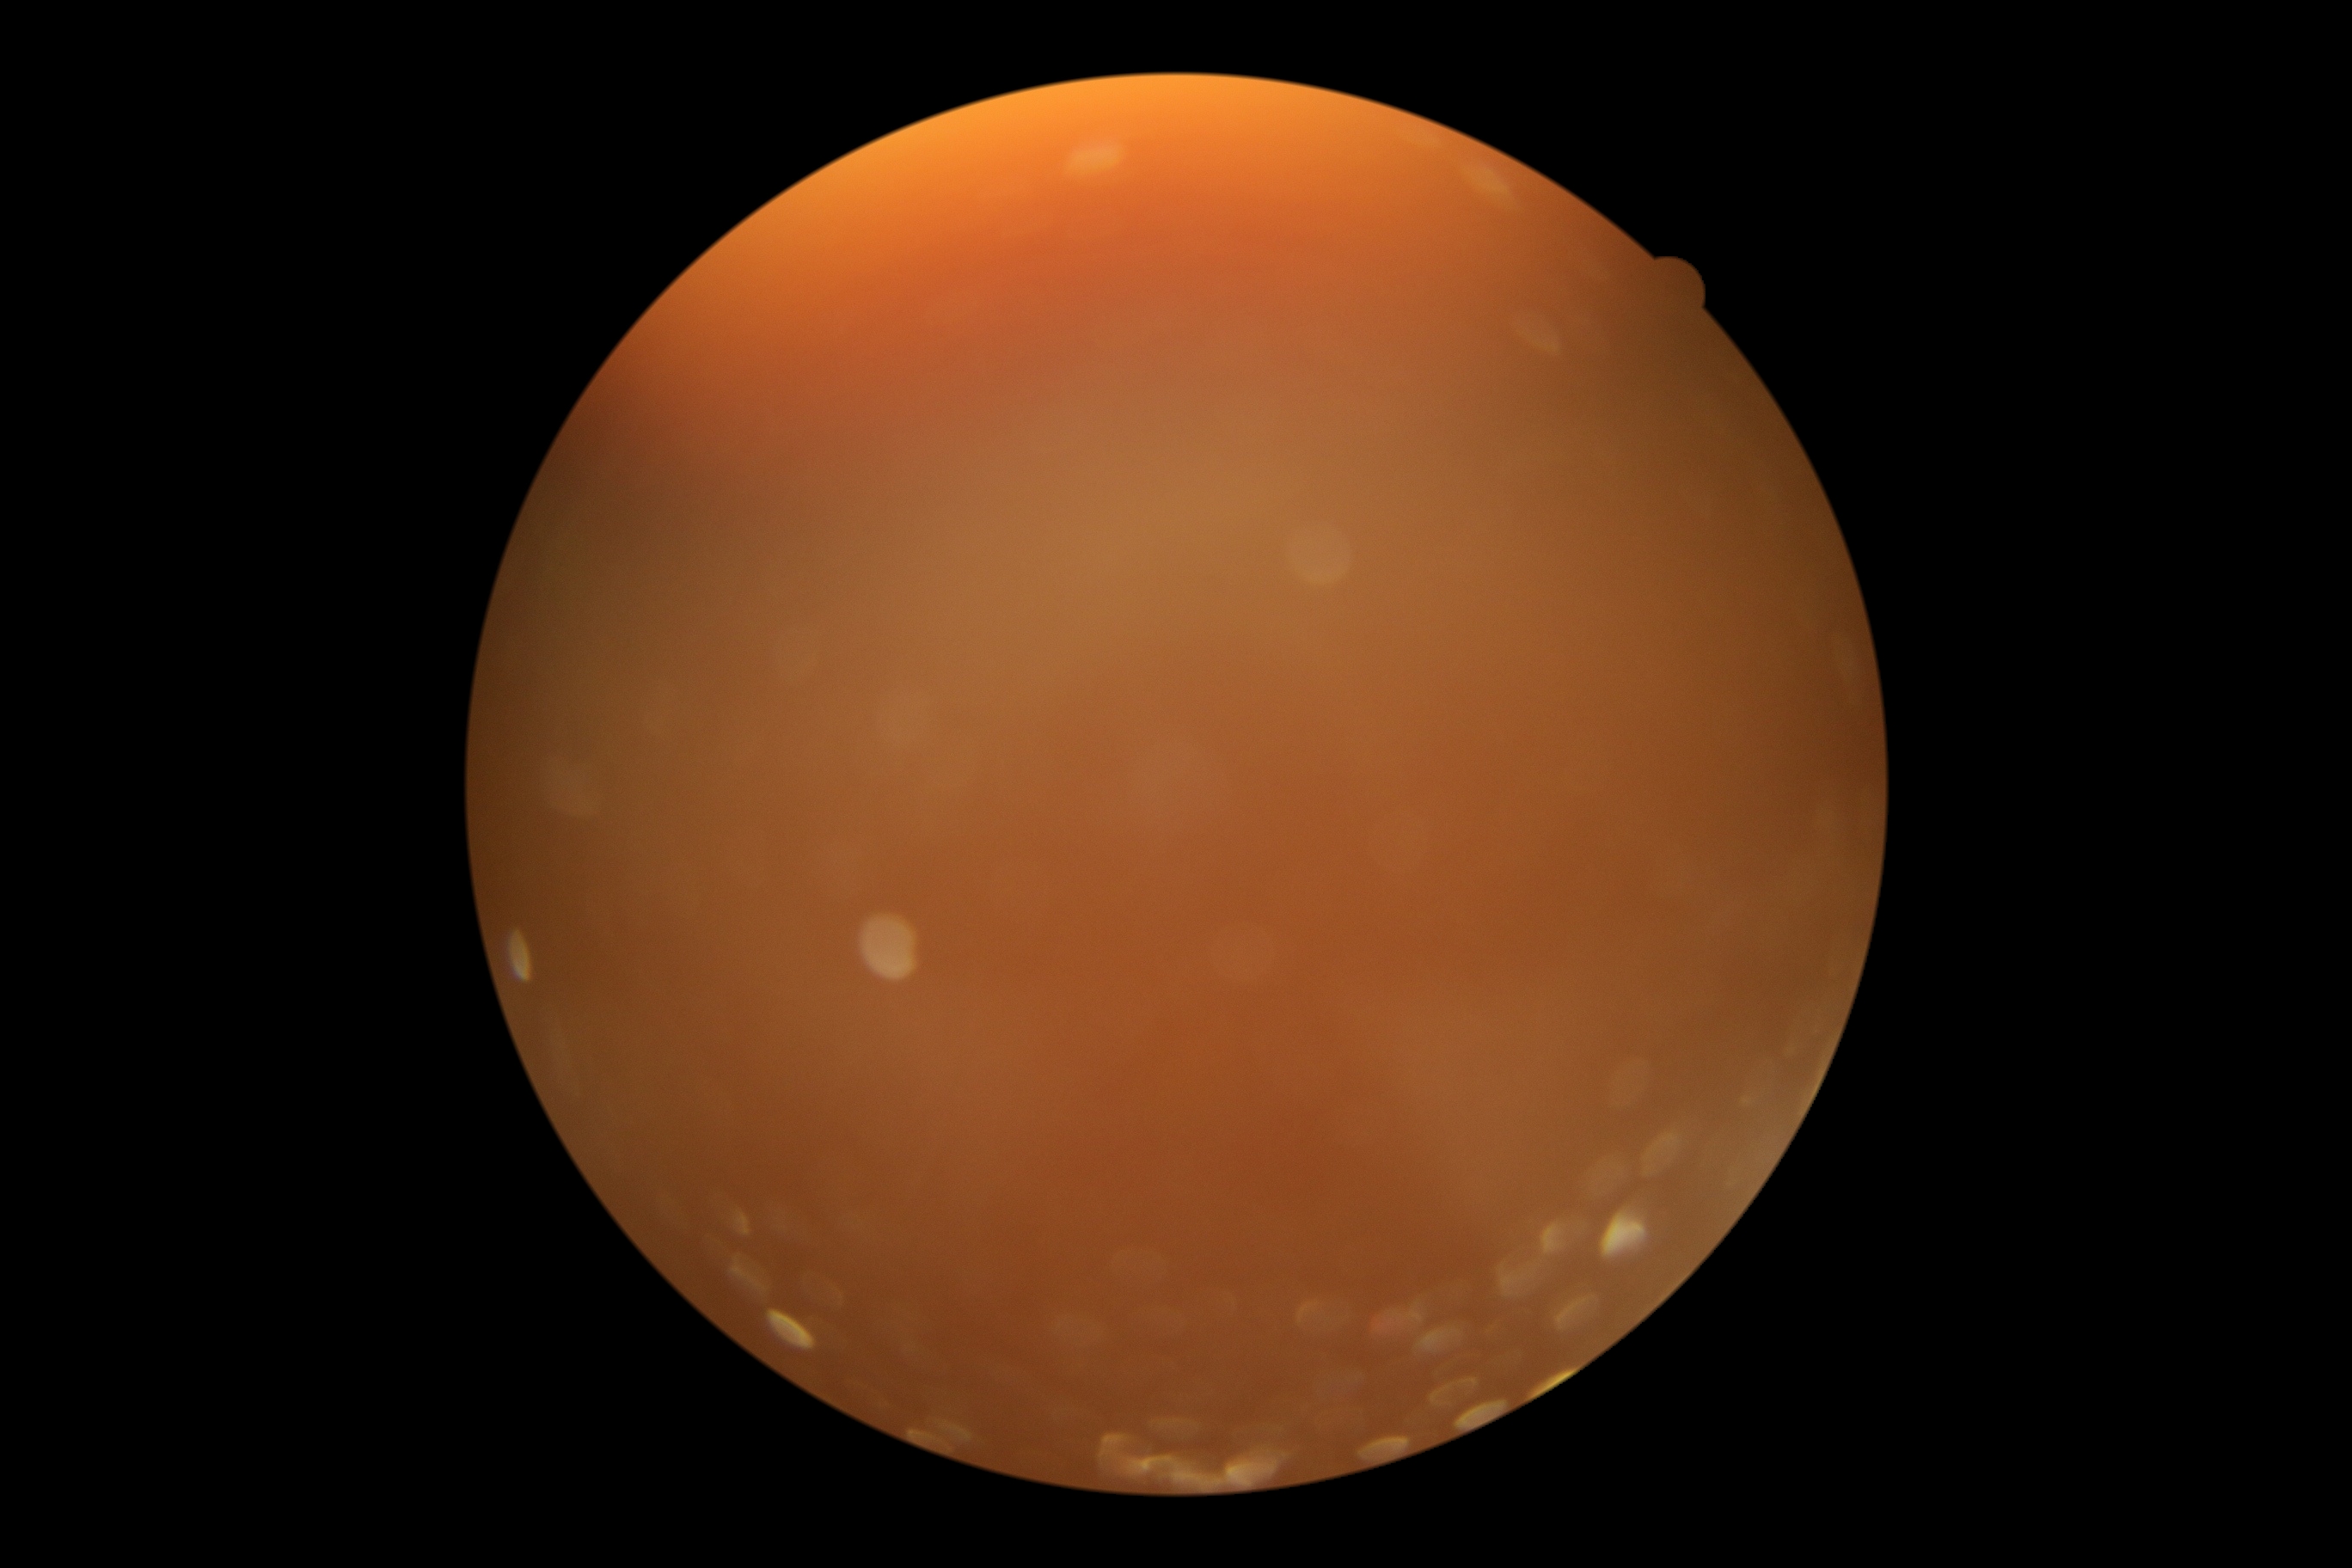
The image cannot be graded for diabetic retinopathy. Diabetic retinopathy (DR) is ungradable due to poor image quality.